512 by 512 pixels. Color fundus image — 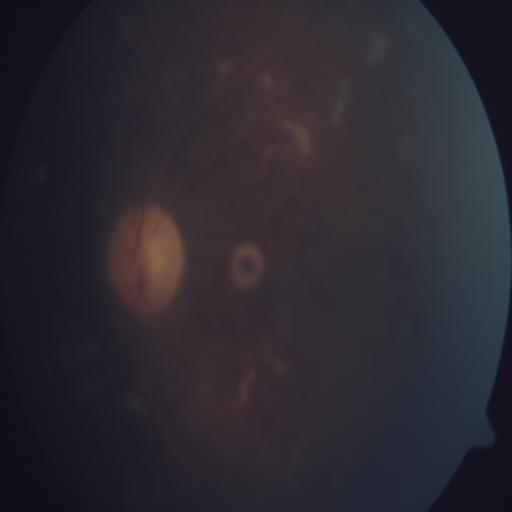
2 abnormalities. Showing cotton wool spots & hemorrhagic retinopathy.